Optic disc photograph — 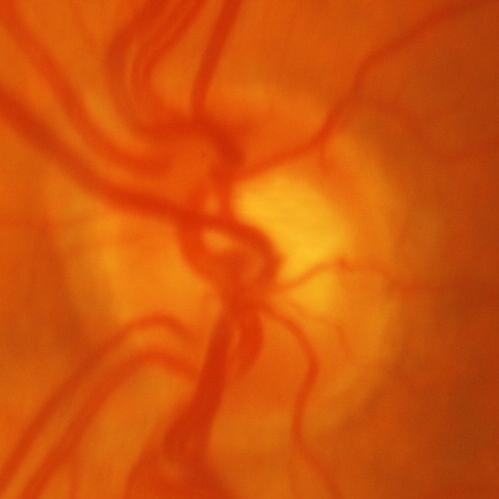 Finding: glaucoma.